45° field of view; 2212x1659px — 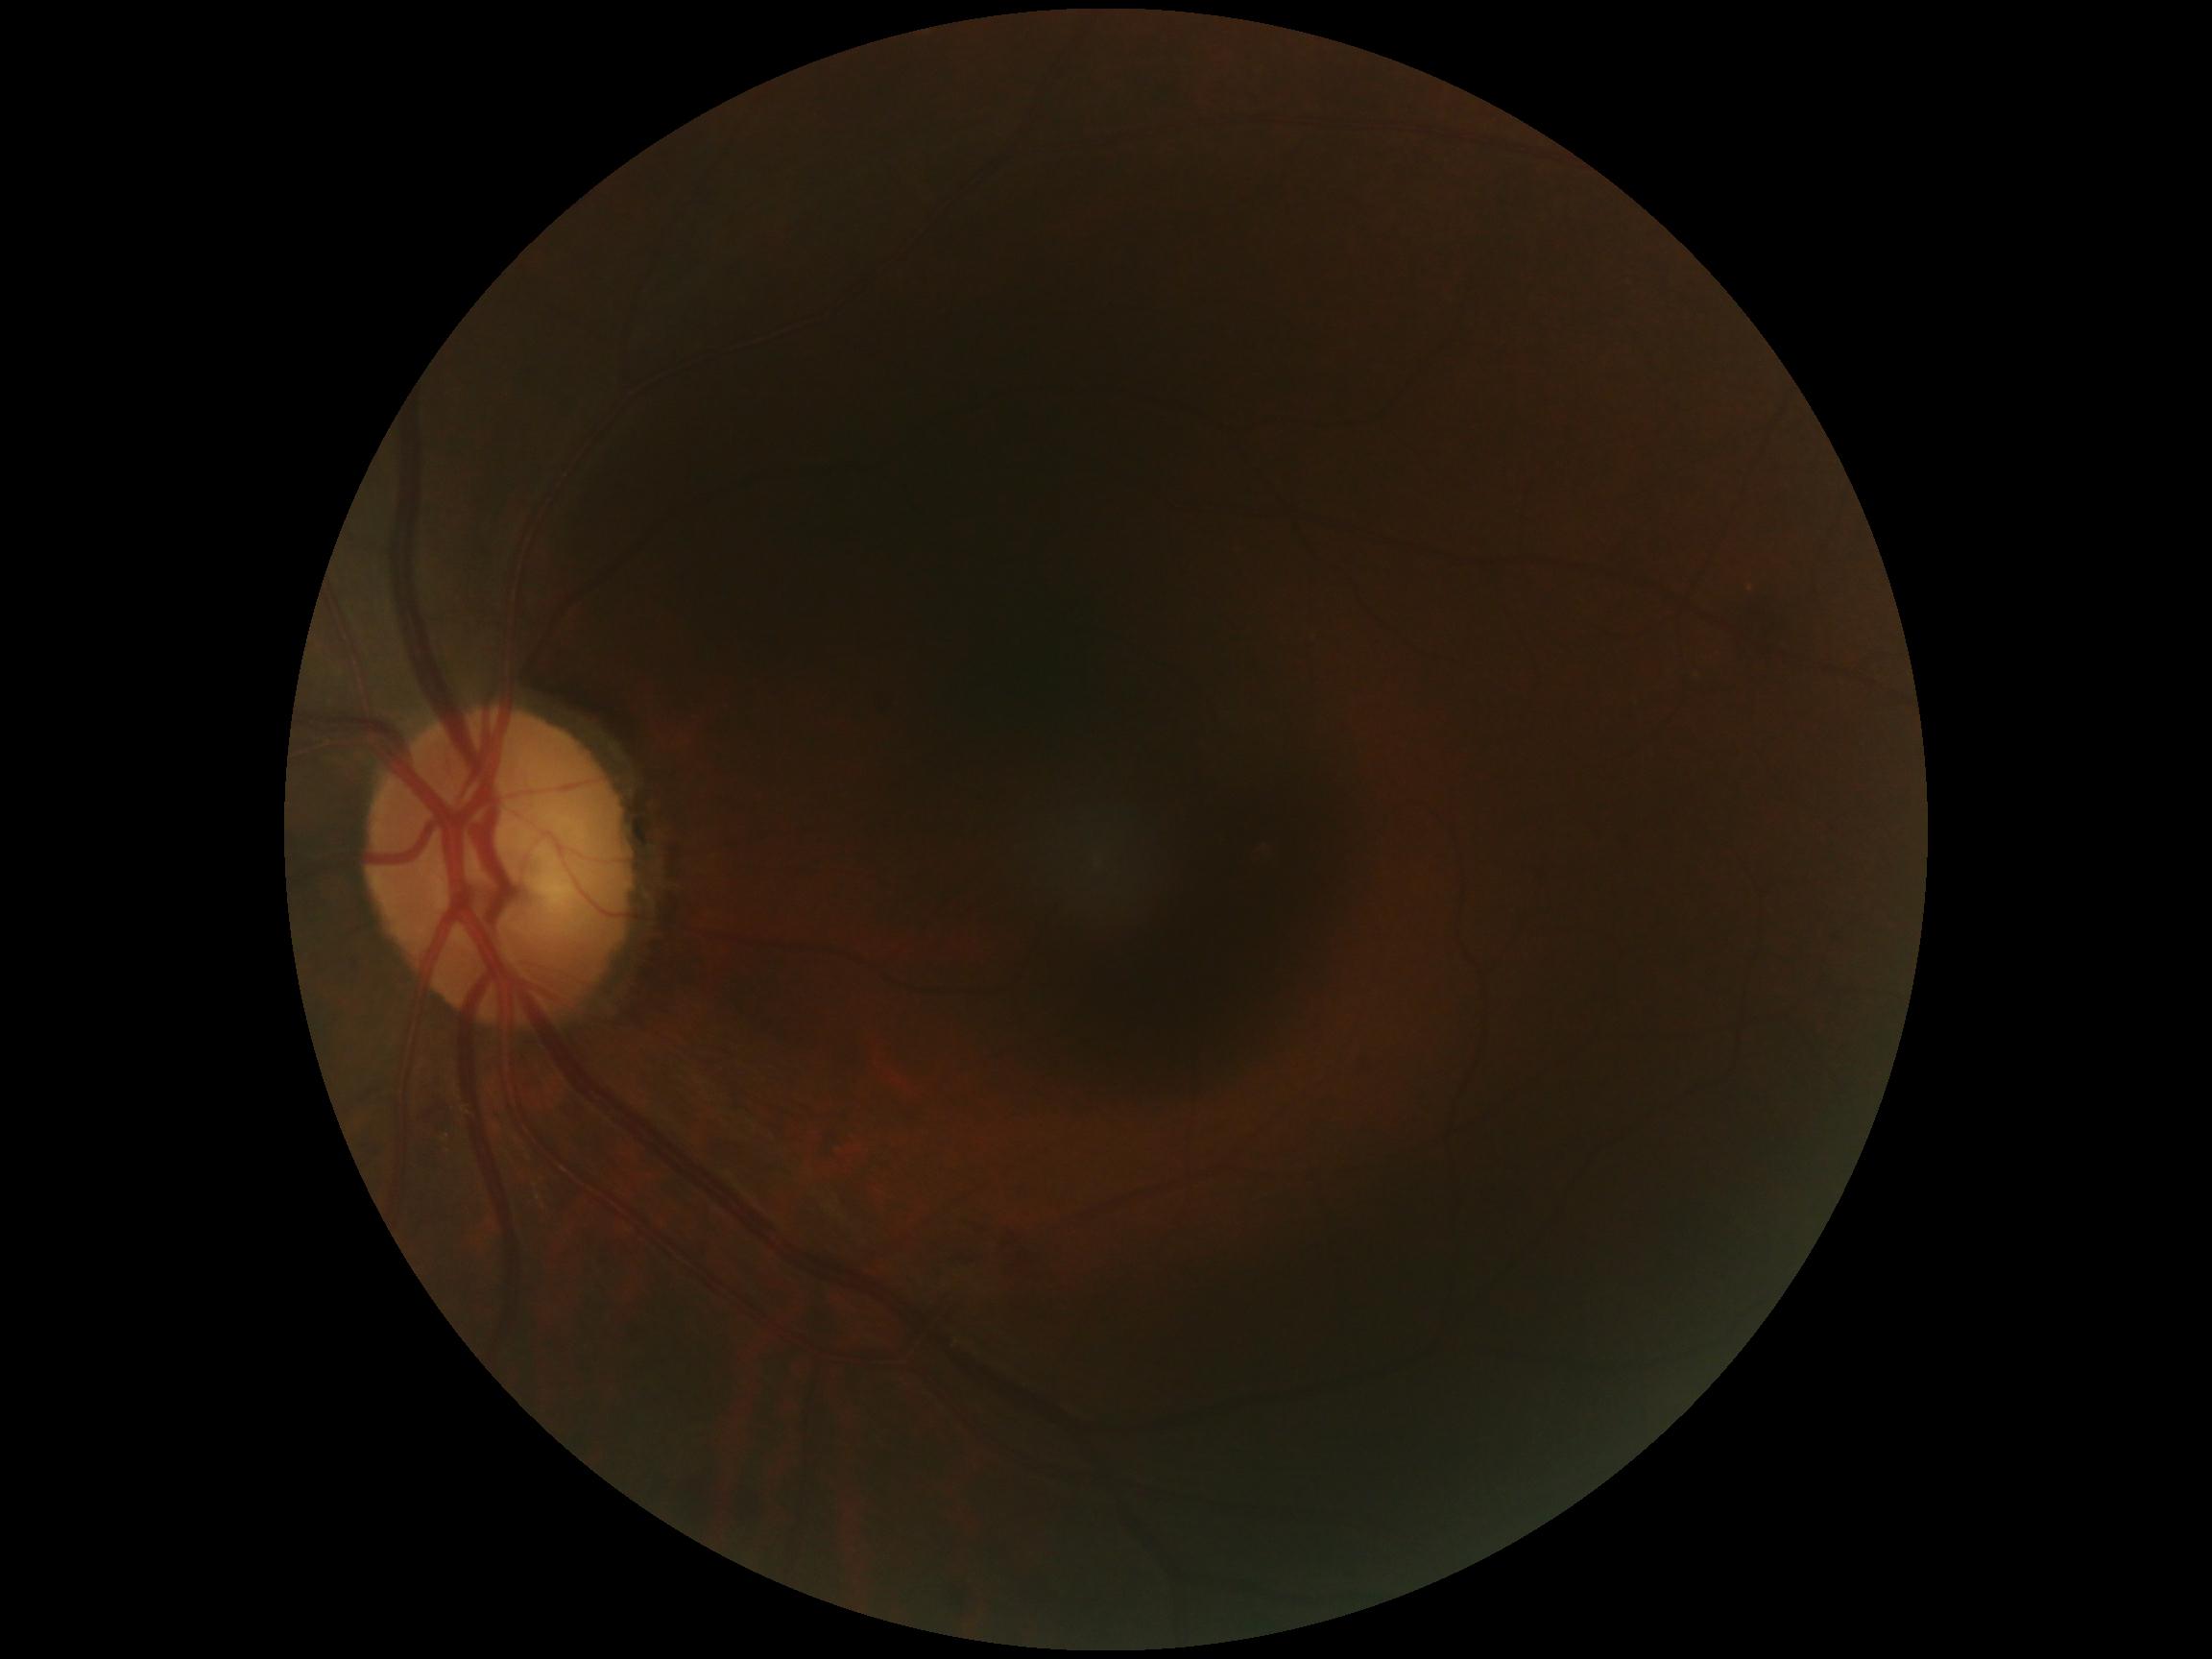
– diabetic retinopathy severity: 2/4
– DR class: non-proliferative diabetic retinopathy